848x848.
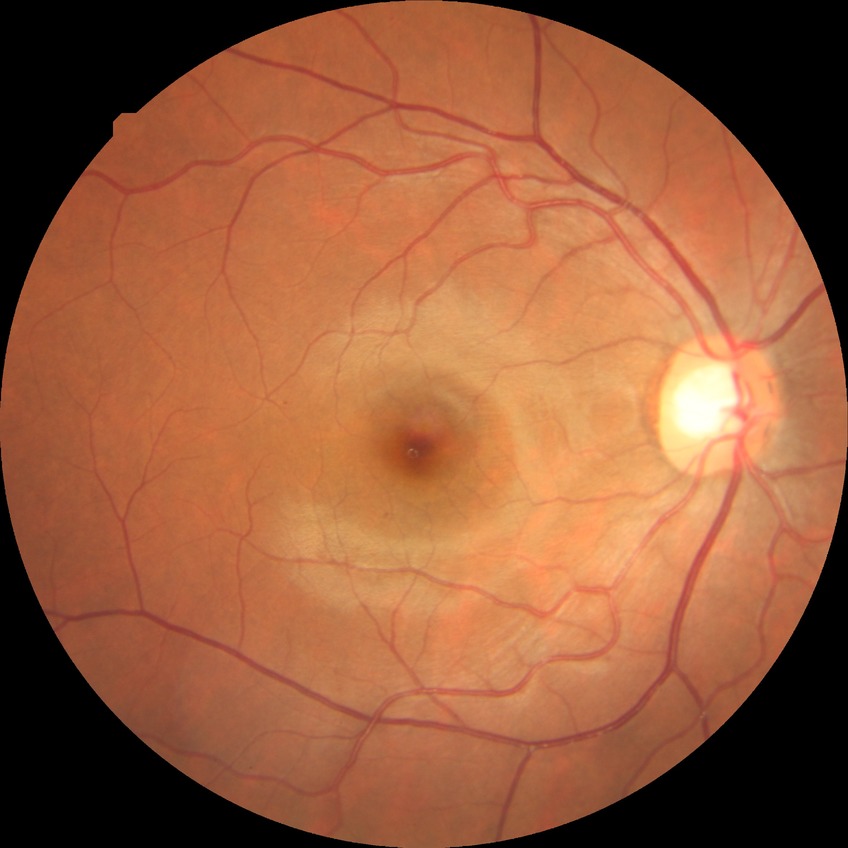 Davis stage: SDR.